Captured with the Phoenix ICON (100° field of view) · wide-field fundus photograph from neonatal ROP screening:
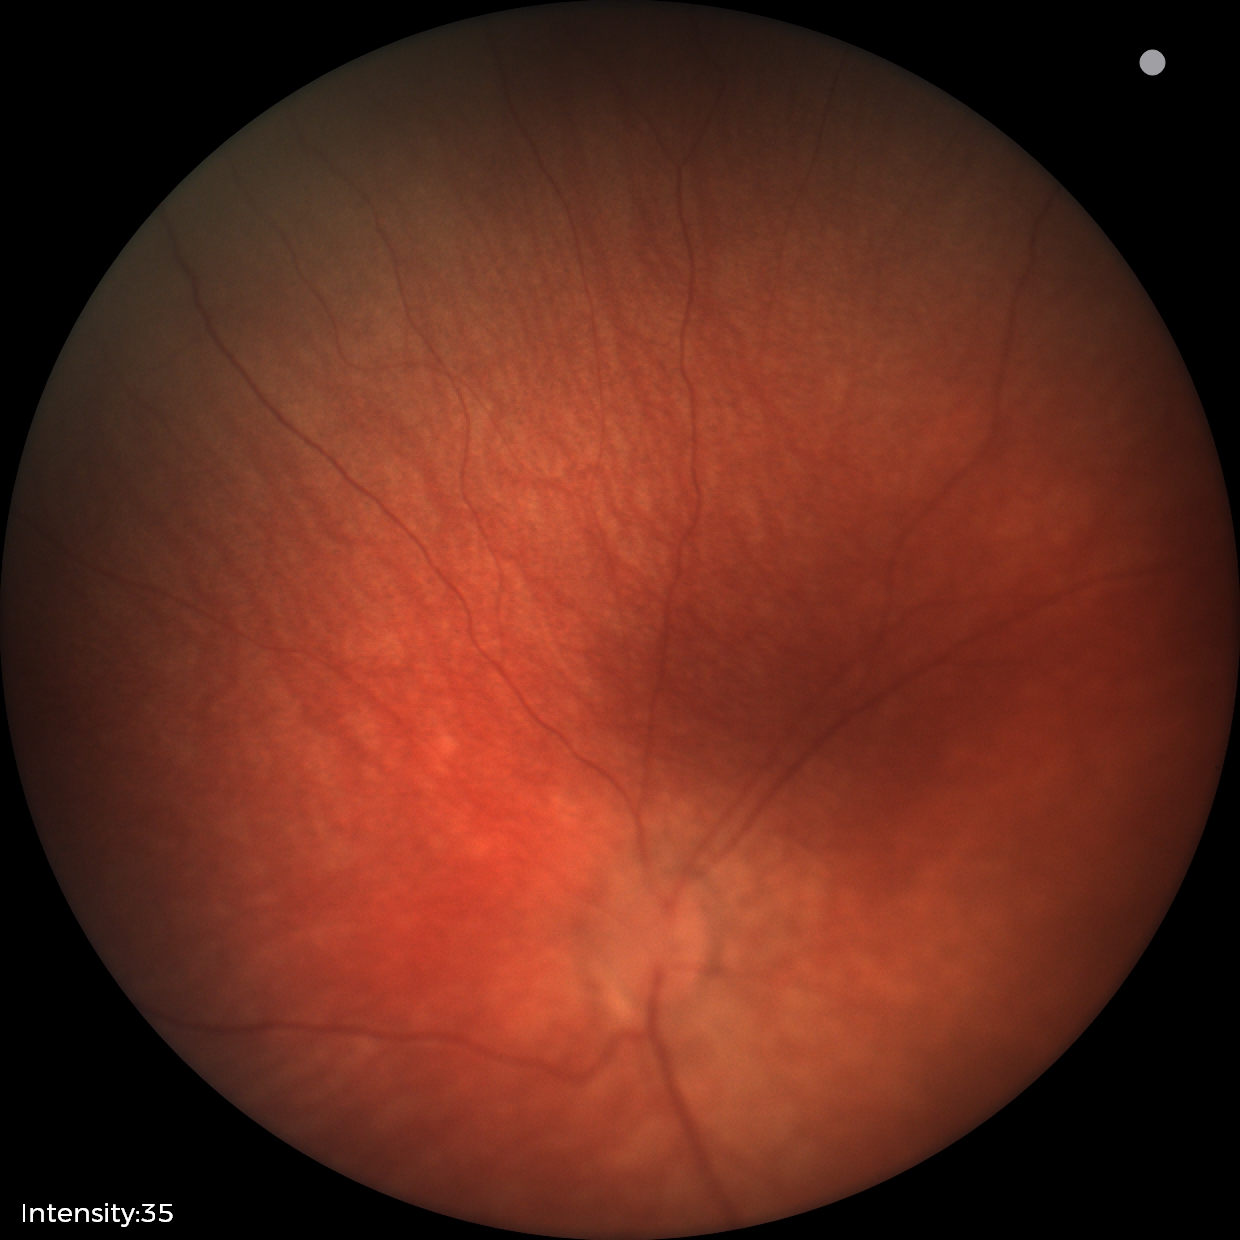

Q: What was the screening finding?
A: physiological finding